Ultra-widefield (UWF) fundus image
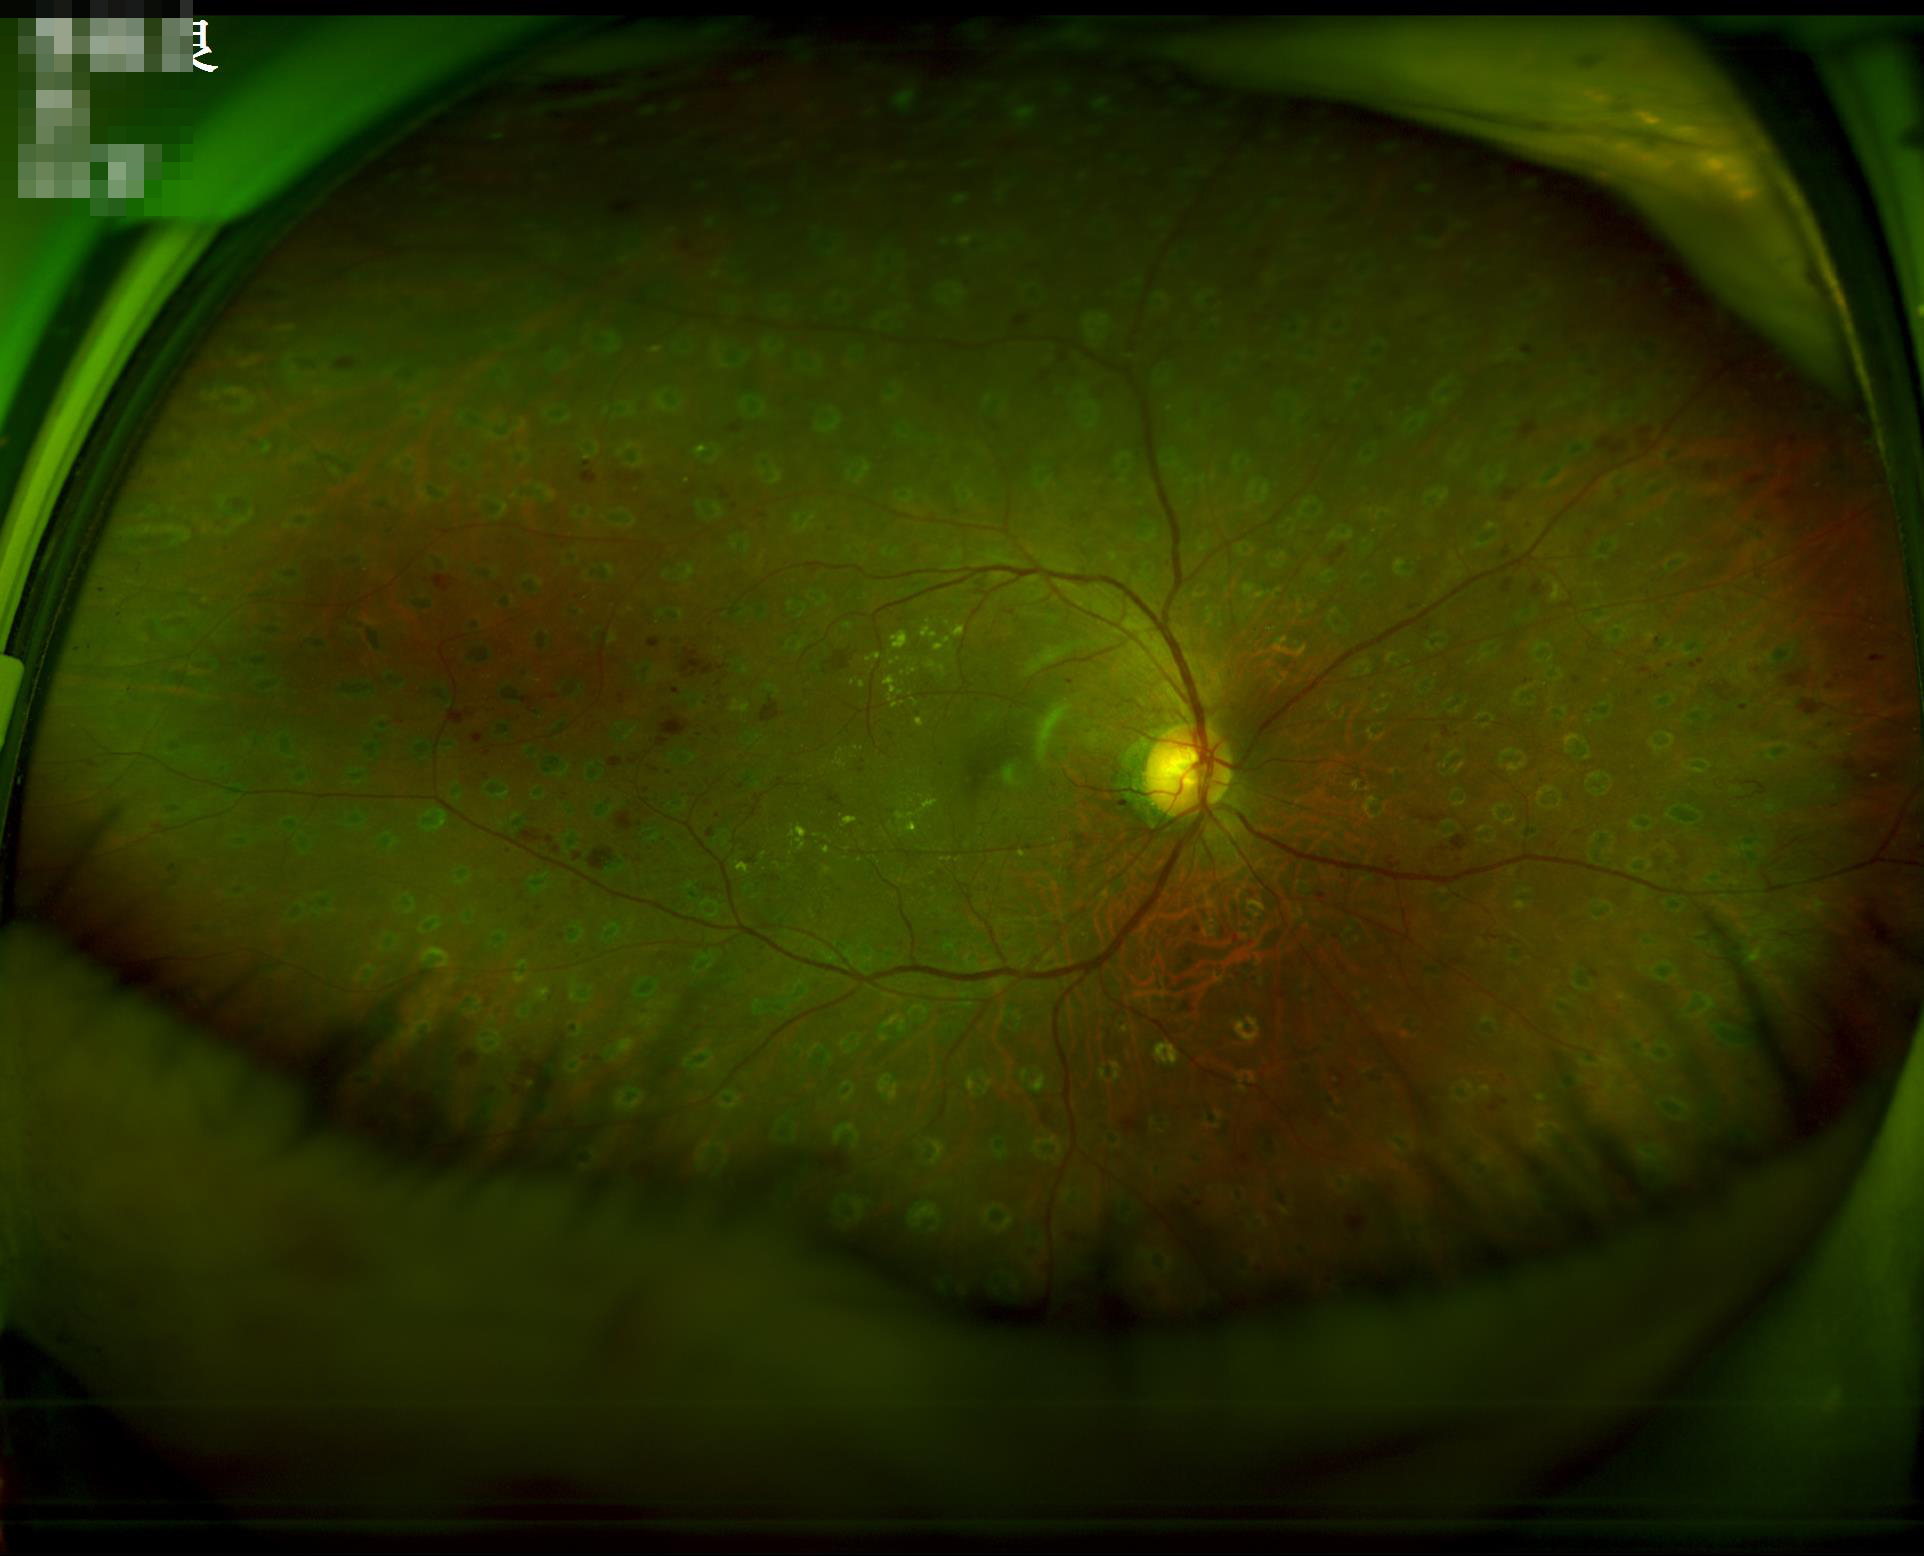   clarity: clear with no noticeable blur
  overall_quality: adequate for clinical interpretation
  illumination: even and well-balanced
  contrast: wide intensity range, structures distinguishable